FOV: 45 degrees · 848 x 848 pixels
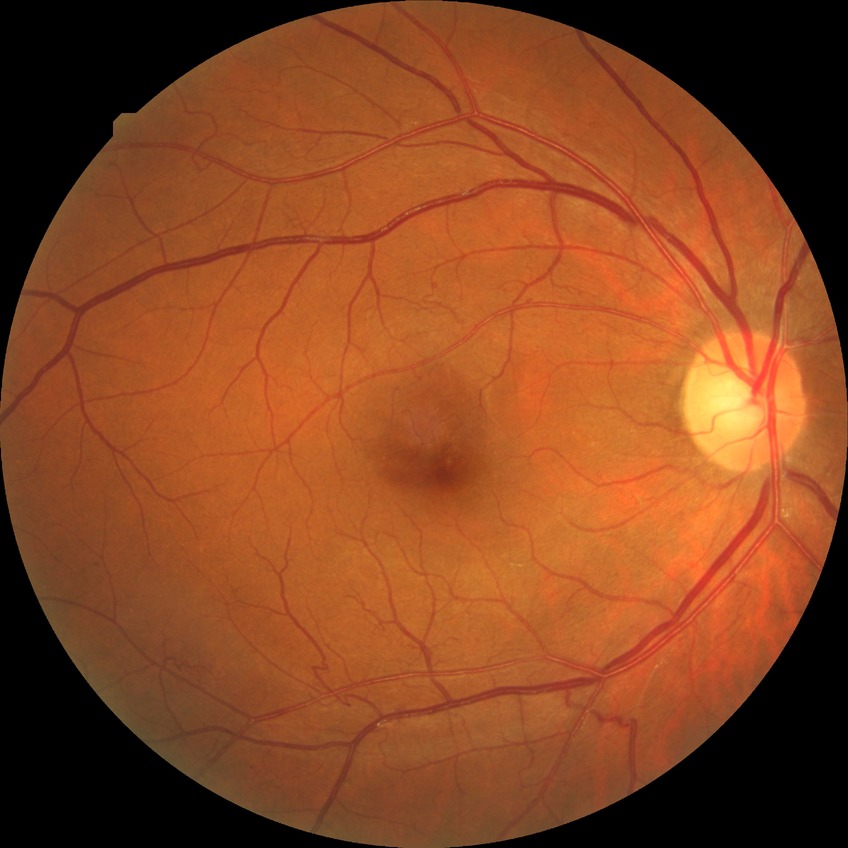

Diabetic retinopathy (DR) is no diabetic retinopathy (NDR).